Modified Davis grading — 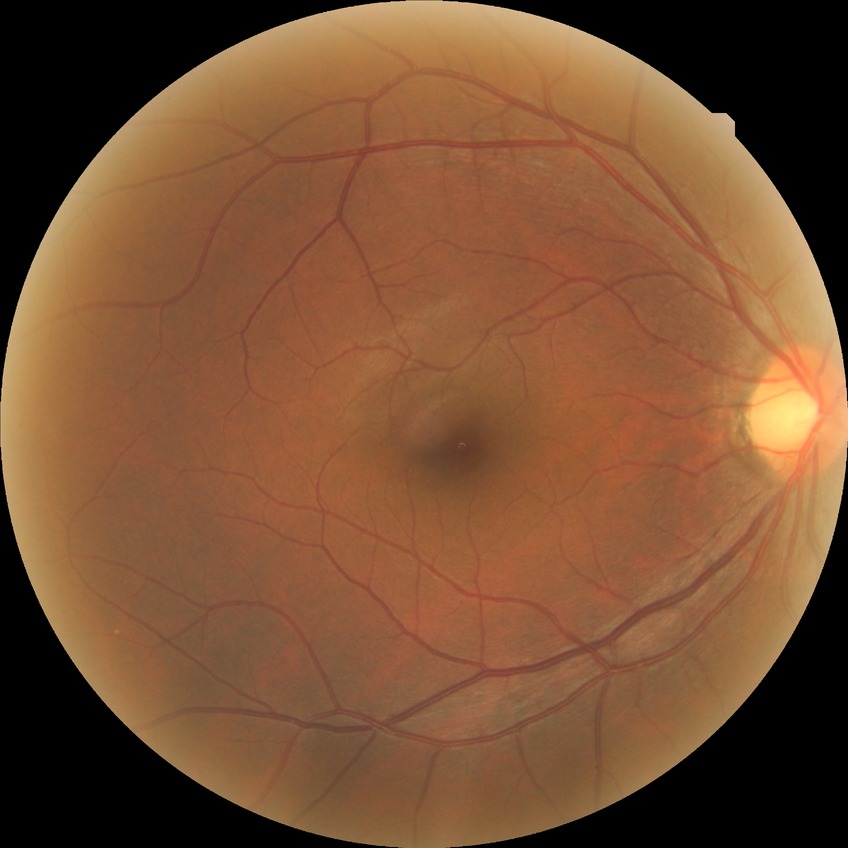

Davis grading is no diabetic retinopathy.